Posterior pole photograph — 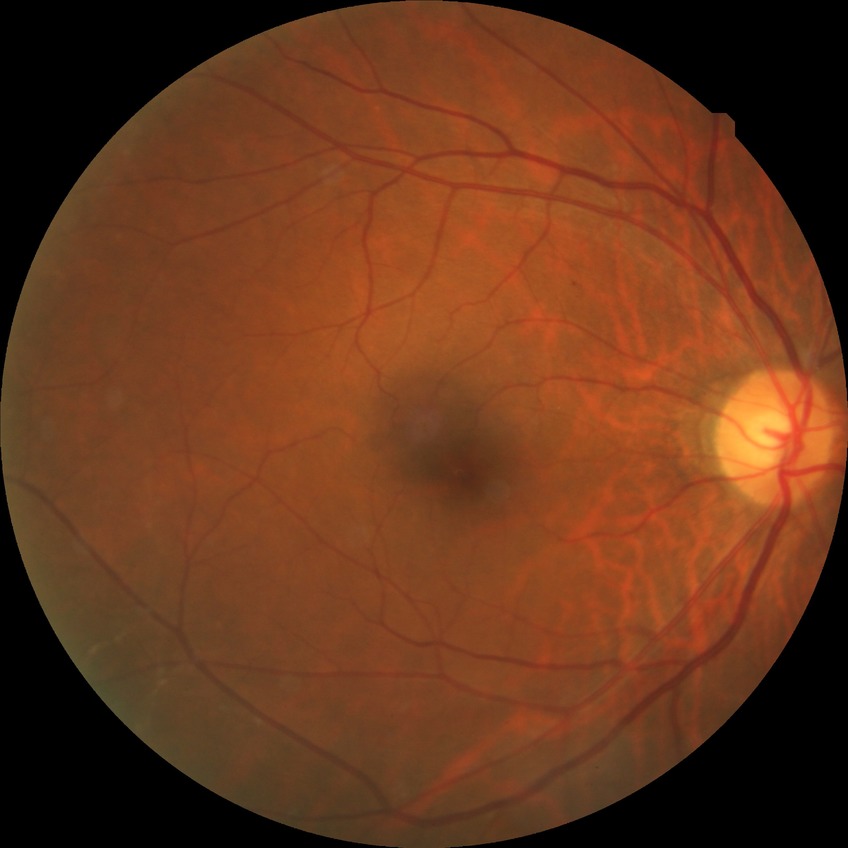 Diabetic retinopathy (DR) is simple diabetic retinopathy (SDR).